Topcon TRC-NW400. Non-mydriatic acquisition. Color fundus photograph. 30° field of view.
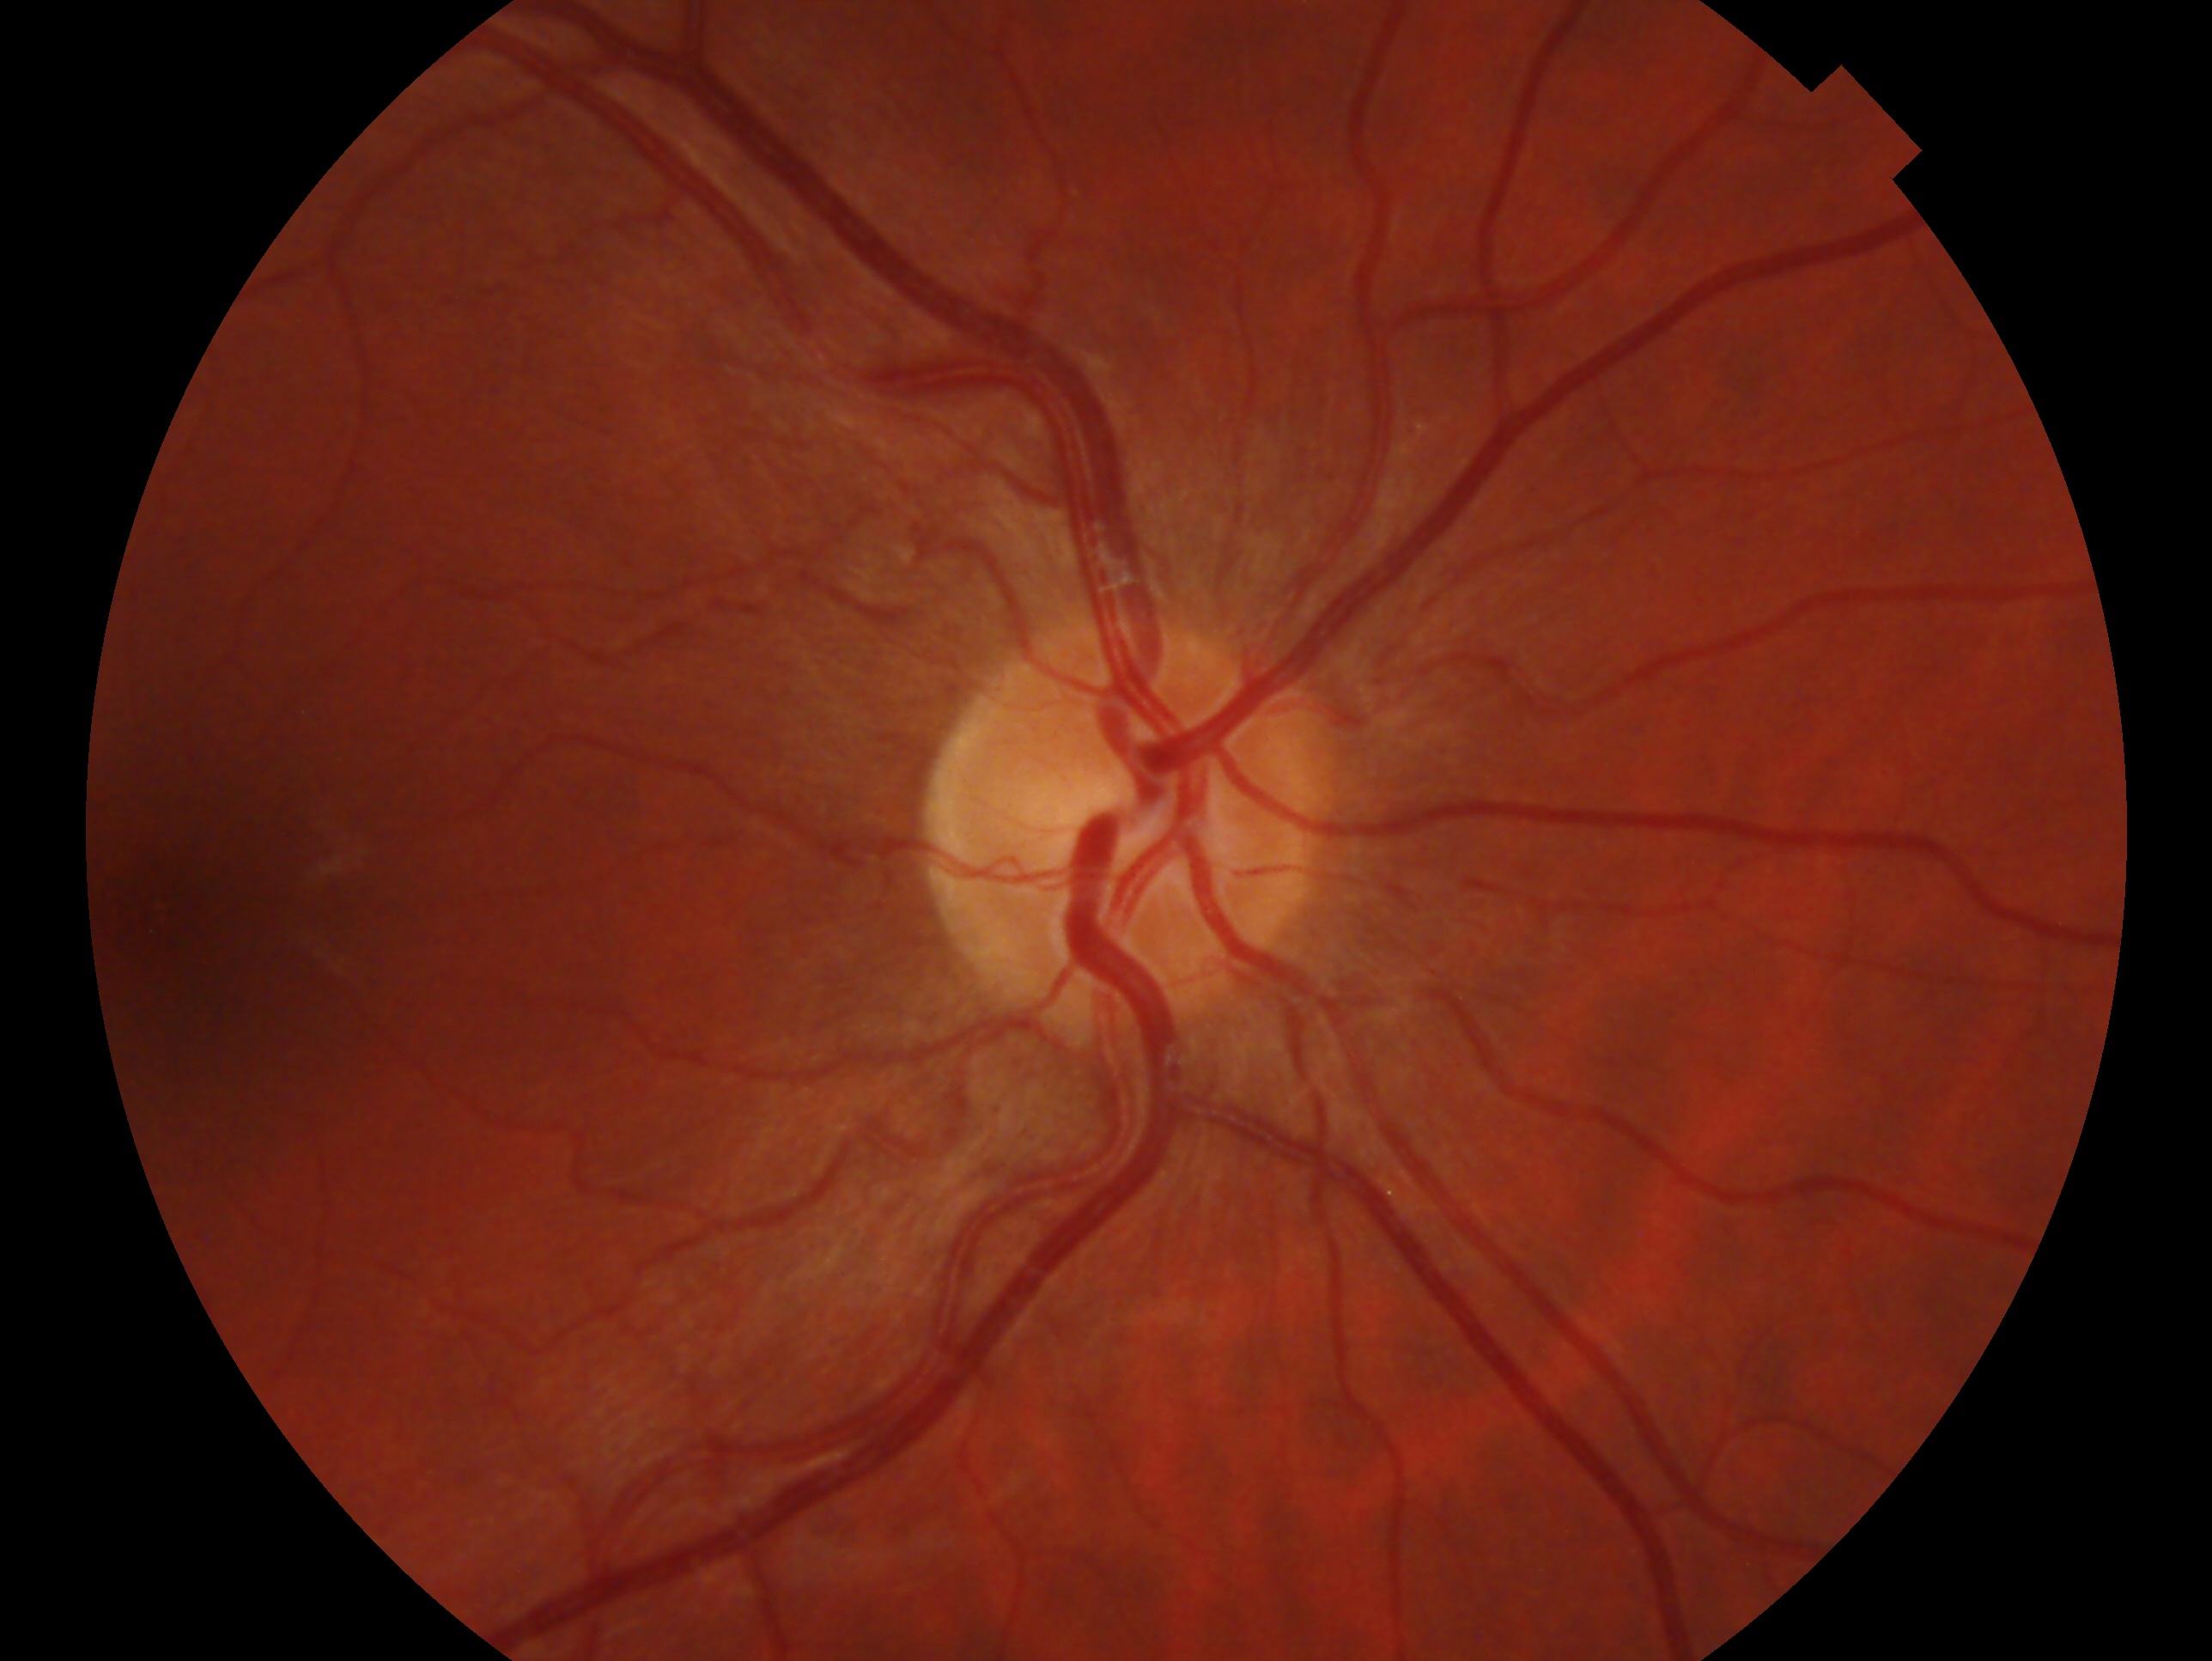 Clinical classification — no glaucoma. Eye: right eye.